Acquired with a Forus 3Nethra Classic fundus camera · 2048x1536:
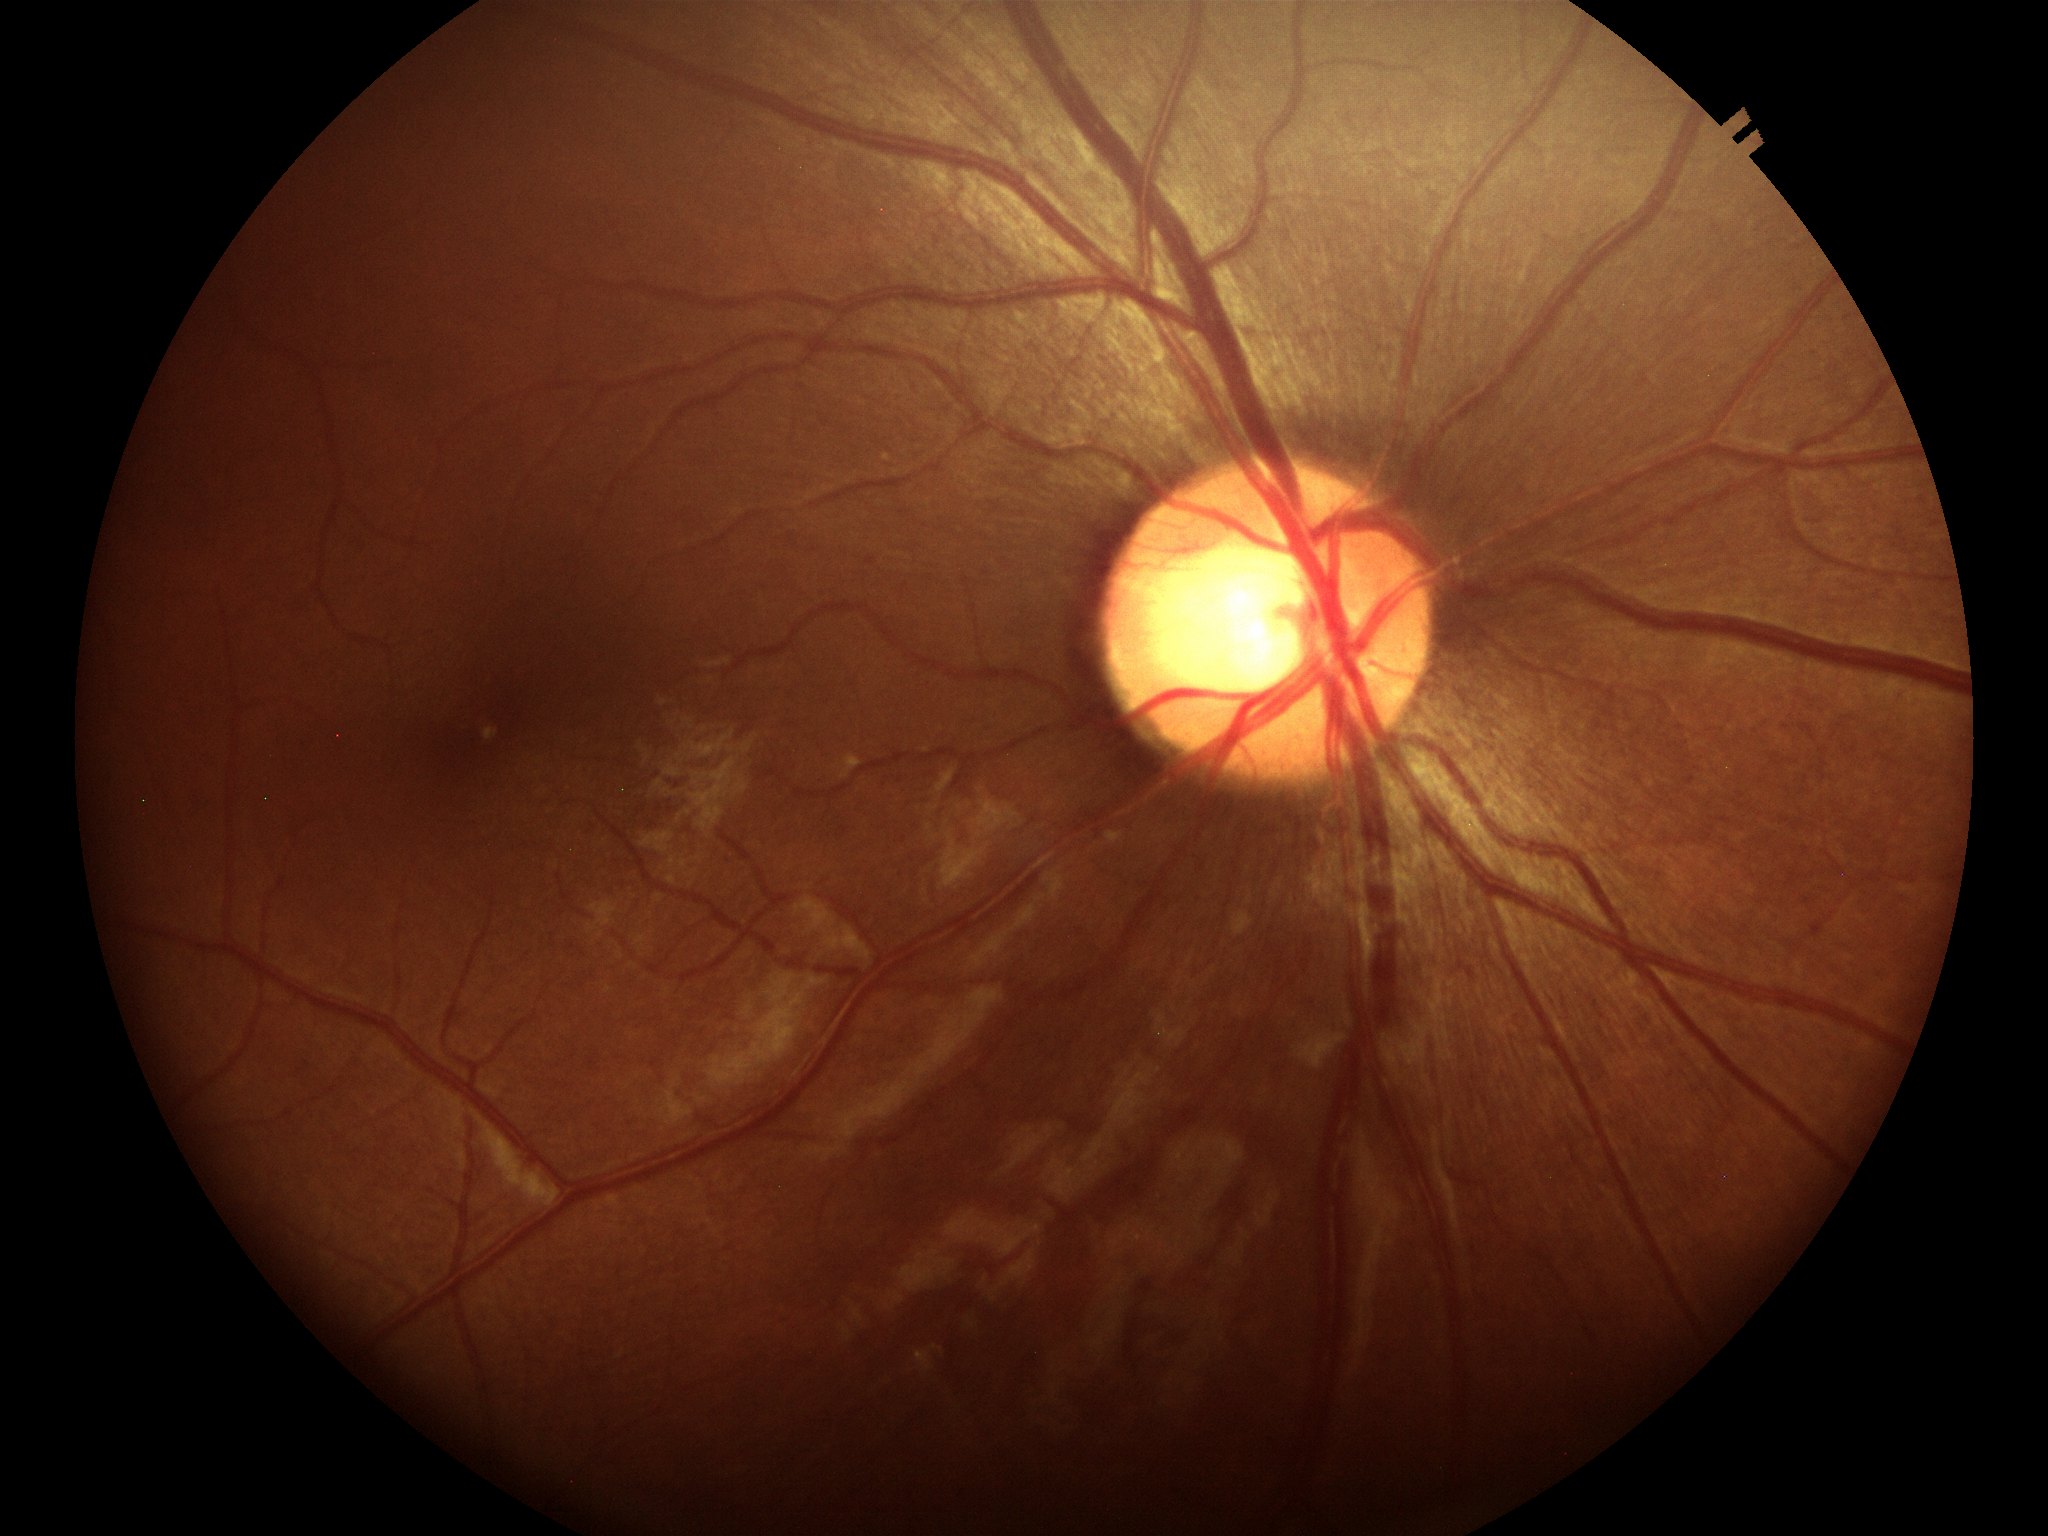
Glaucoma assessment = negative; vertical CDR = 0.57.